848x848 · diabetic retinopathy graded by the modified Davis classification
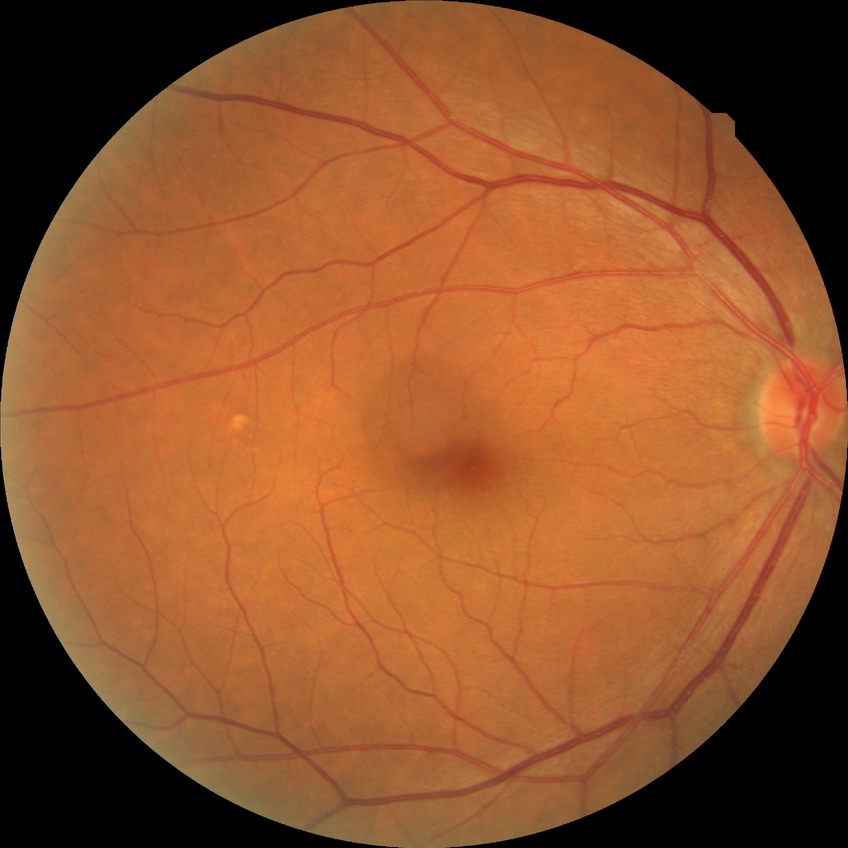
modified Davis grading = no diabetic retinopathy.